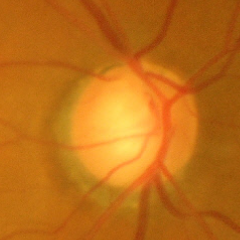 Glaucoma stage: severe glaucomatous damage.